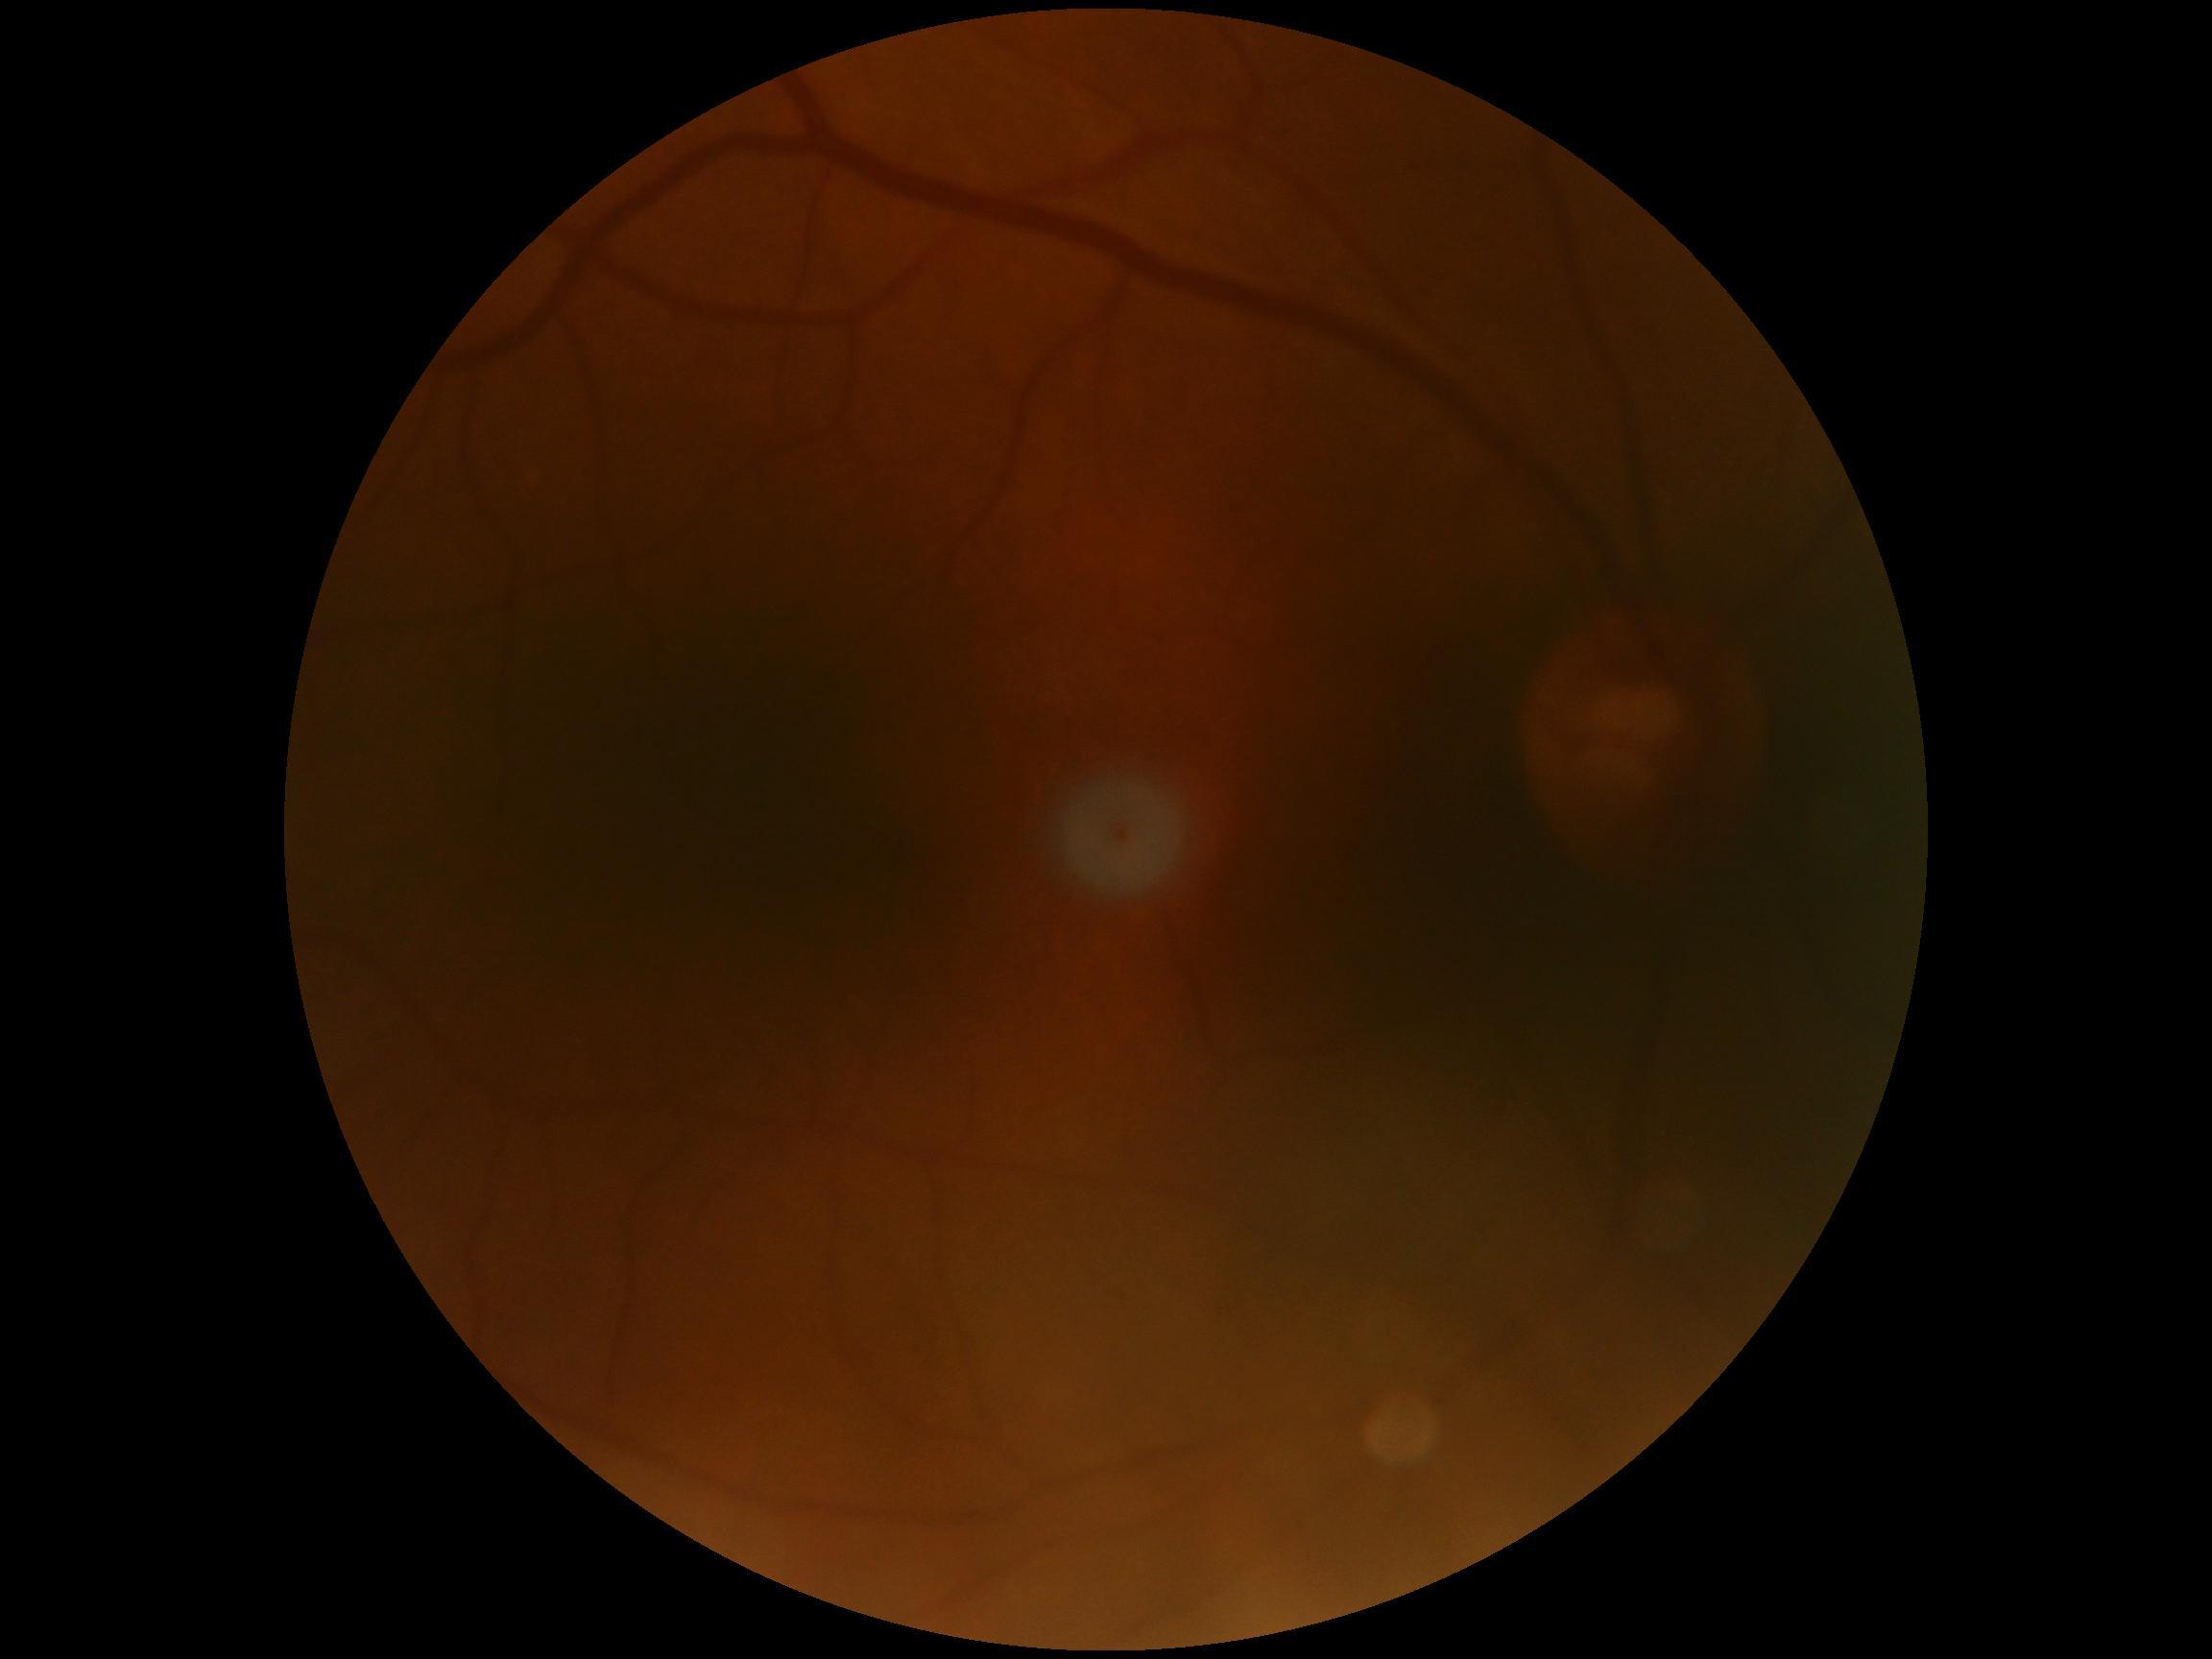

DR grade: 0 (no apparent retinopathy) — no visible signs of diabetic retinopathy.